NIDEK AFC-230 · 45-degree field of view:
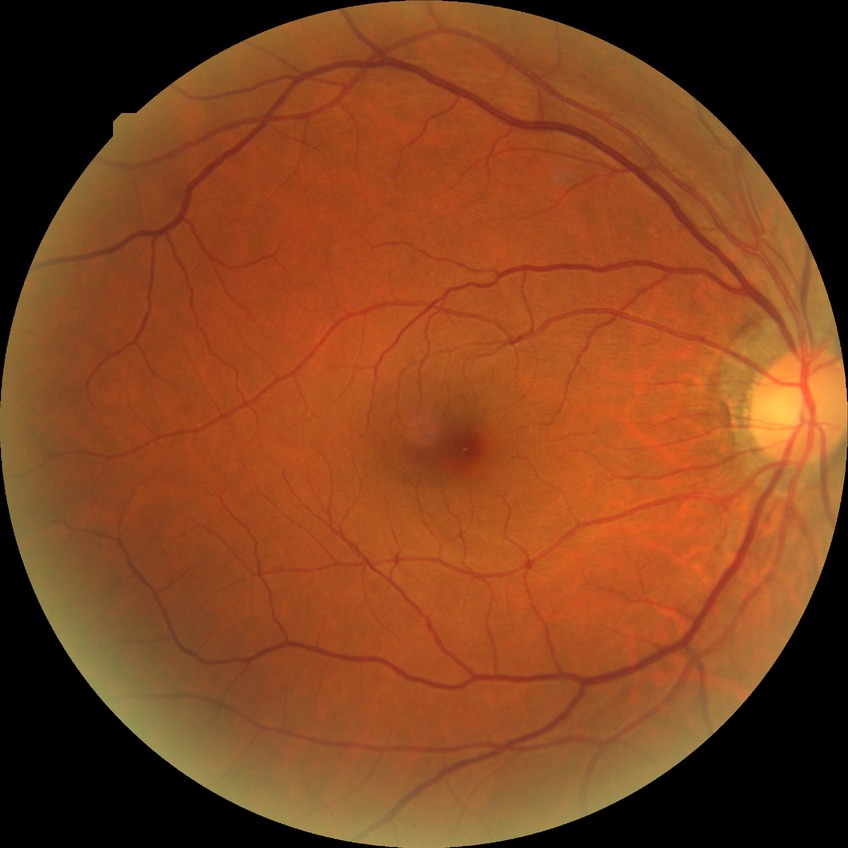
Modified Davis classification: simple diabetic retinopathy.